1932x1910px; 45° field of view.
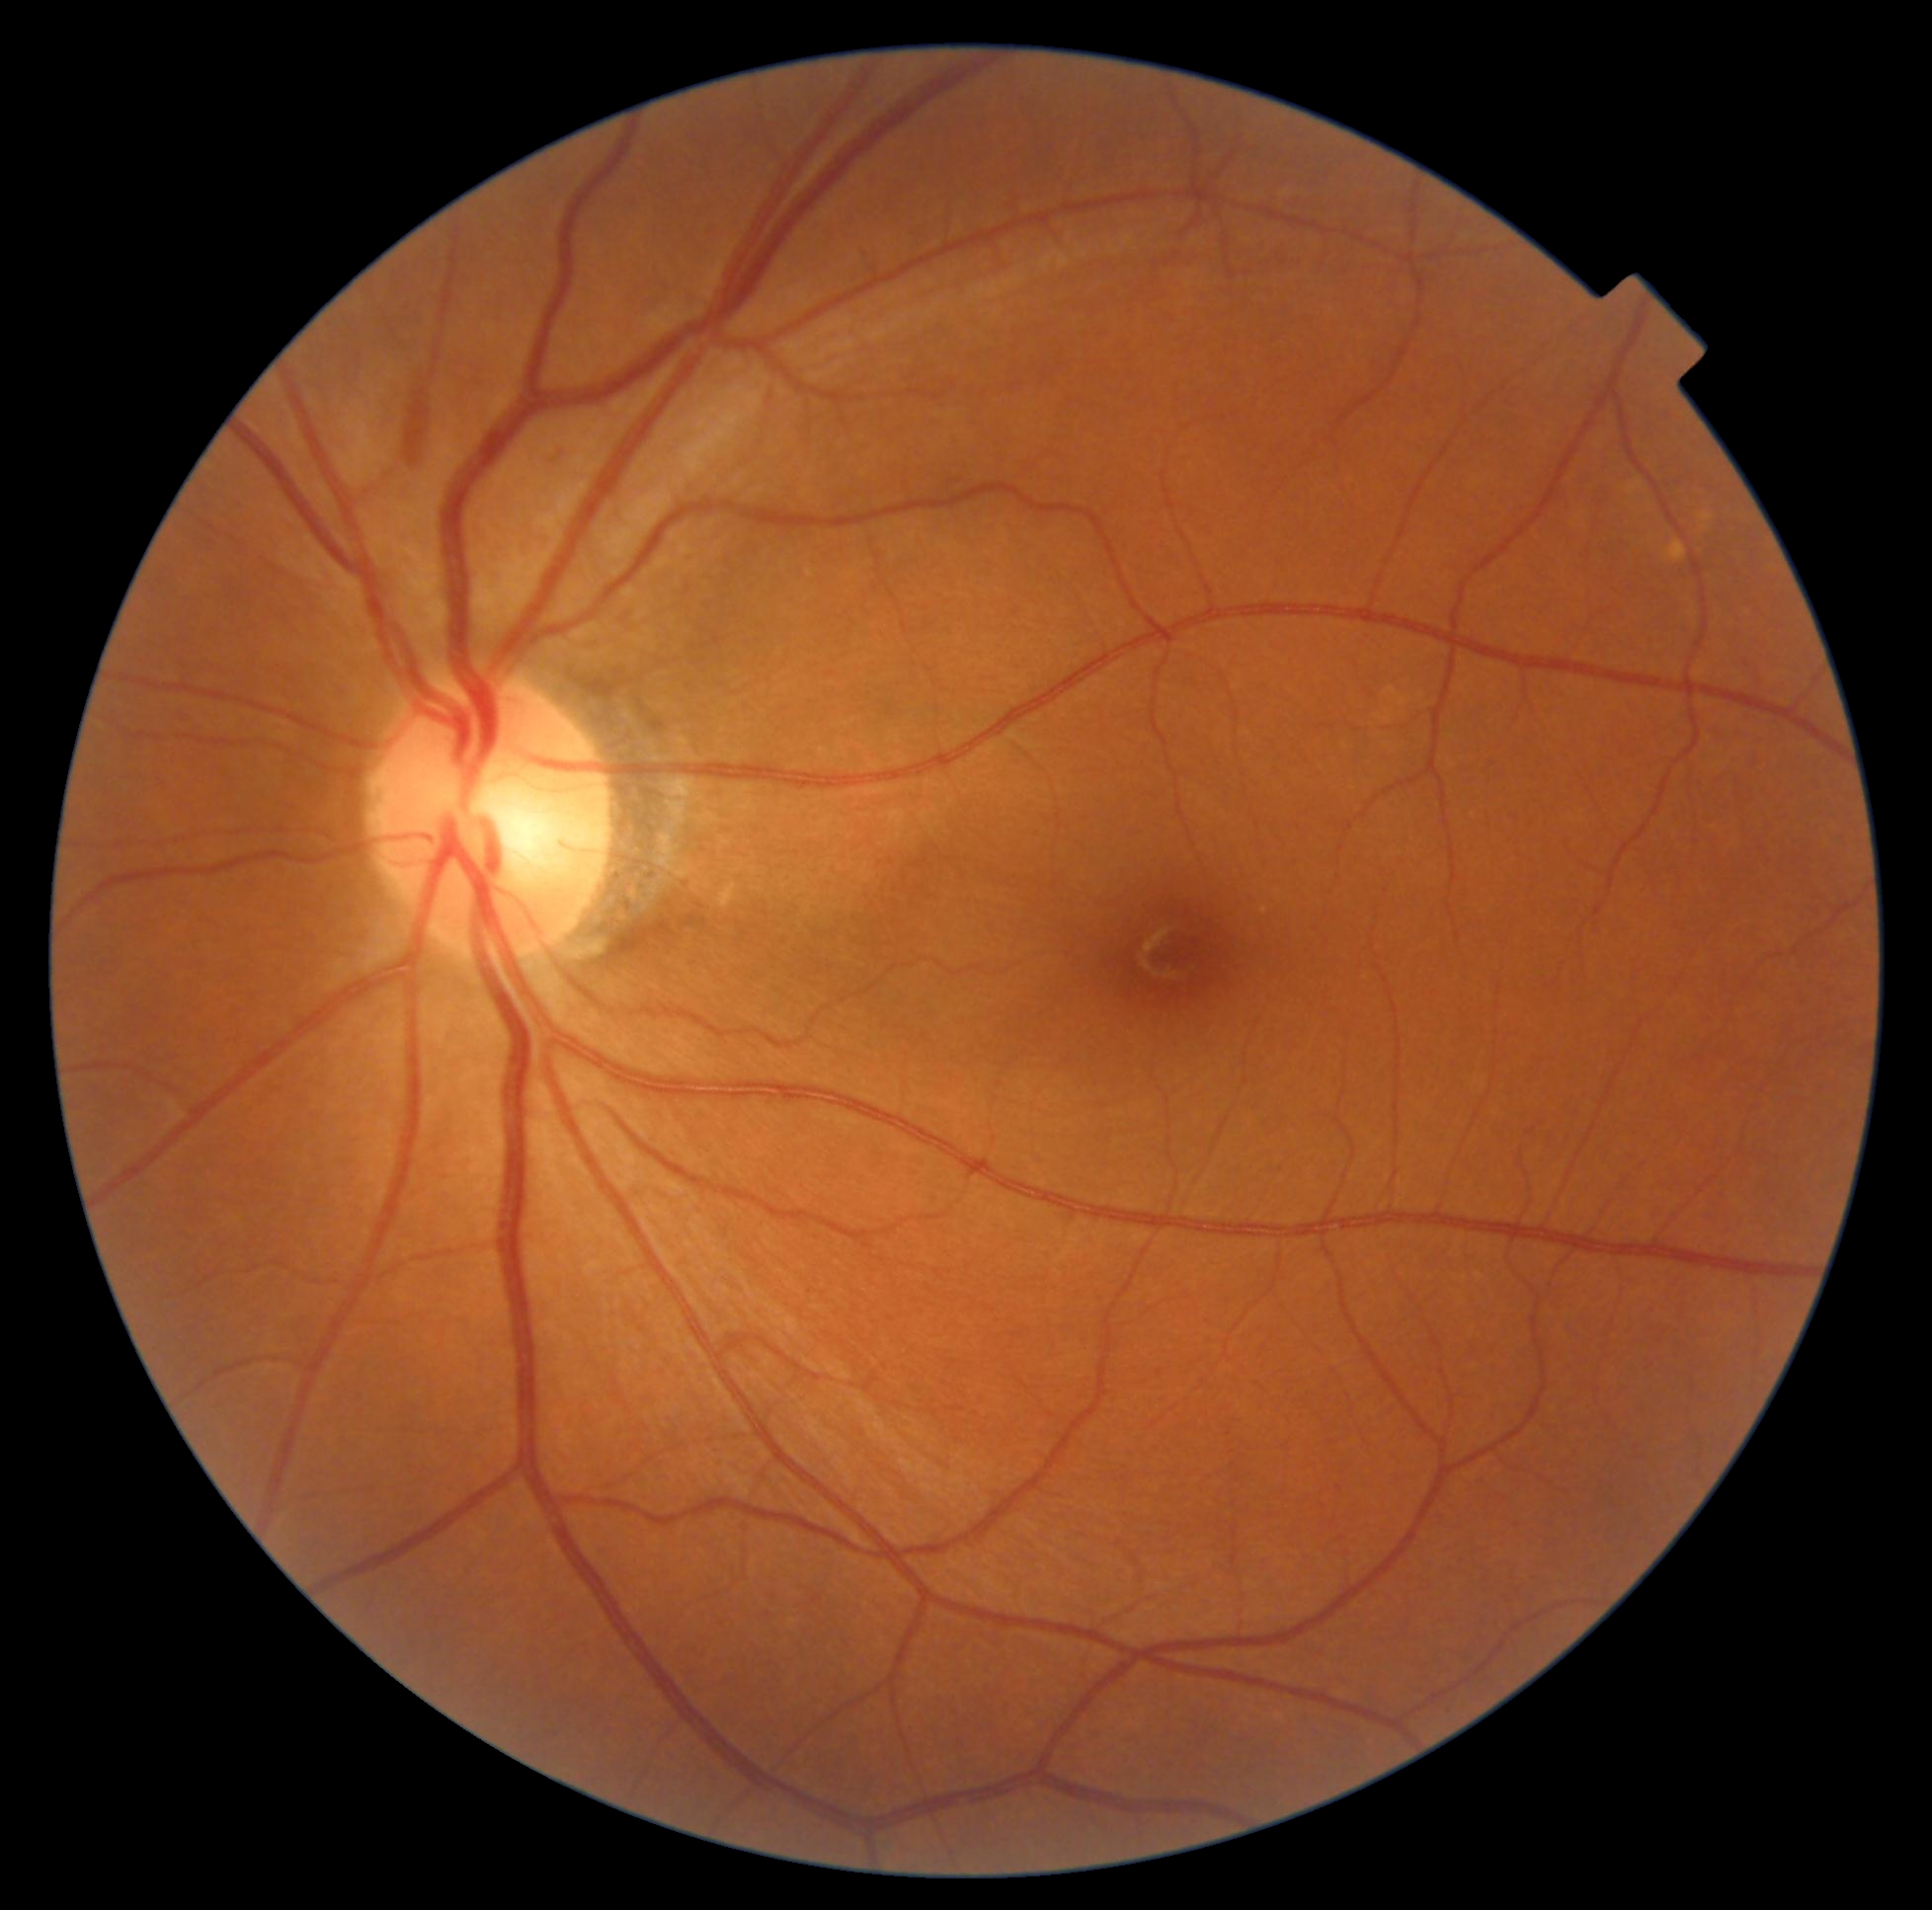 Diabetic retinopathy (DR): moderate NPDR (grade 2). The retinopathy is classified as non-proliferative diabetic retinopathy.